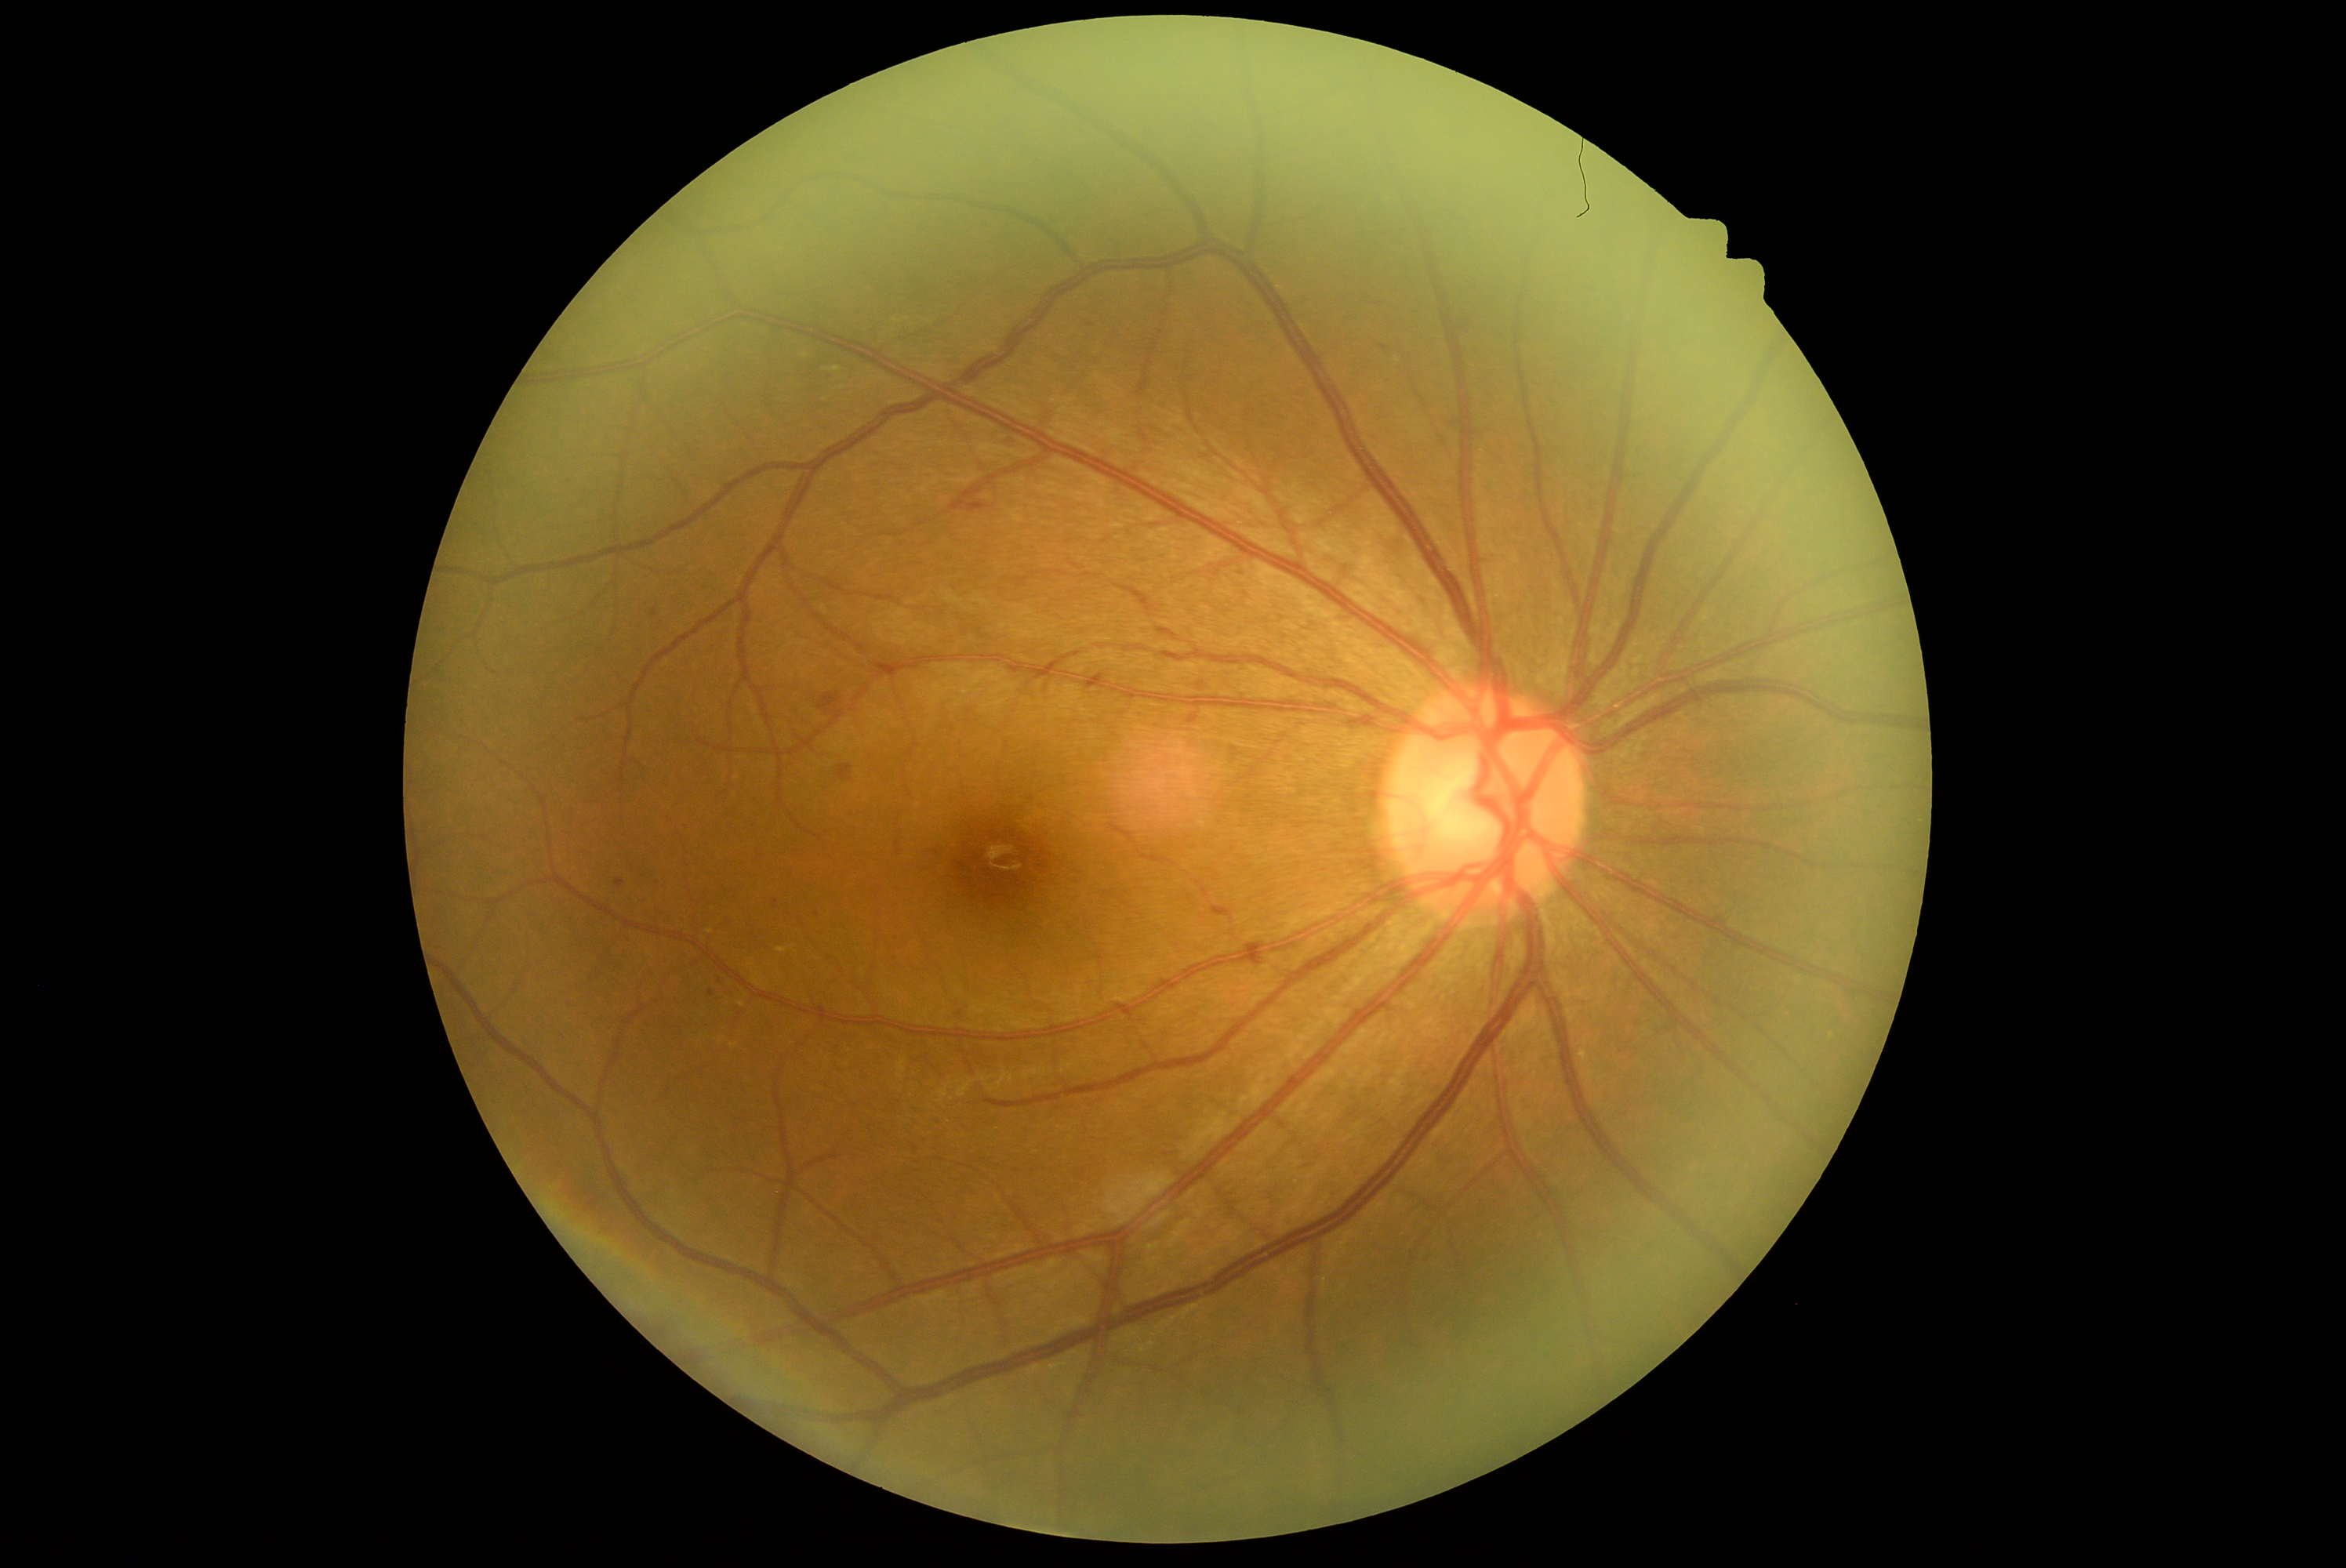
  dr_grade: moderate NPDR (2)
  dr_category: non-proliferative diabetic retinopathy